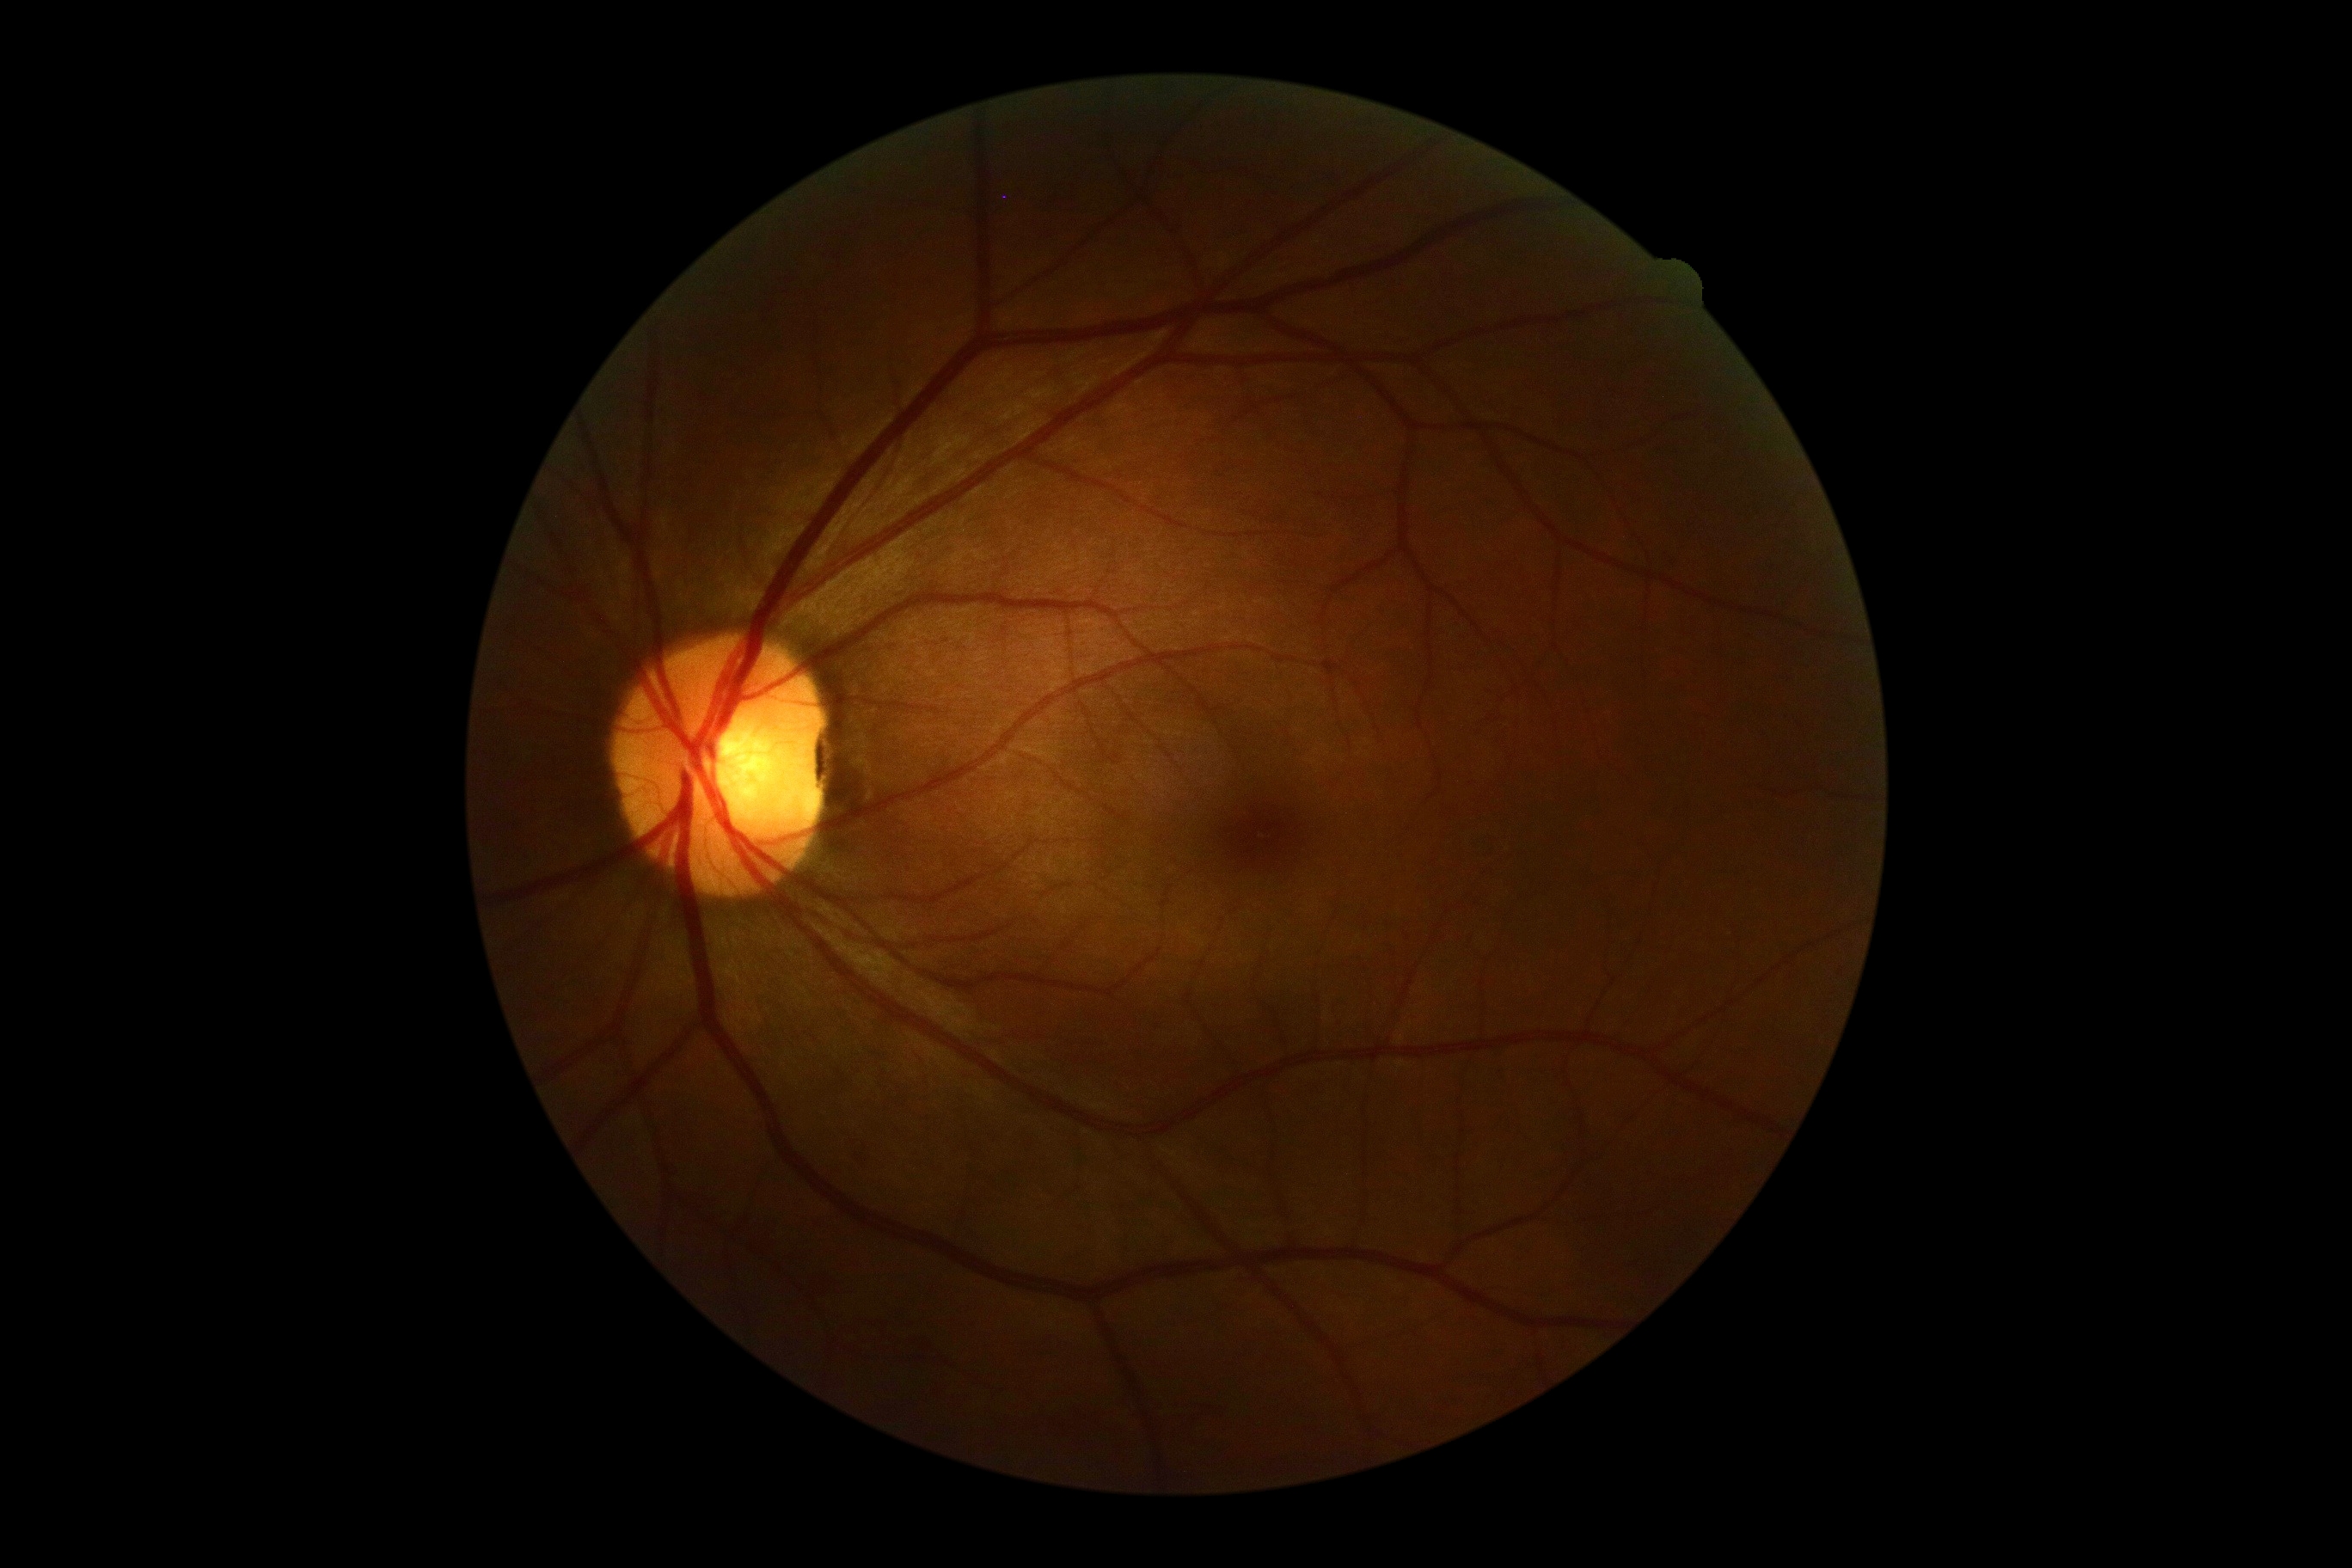

No diabetic retinal disease findings.
DR grade: no apparent diabetic retinopathy (0).